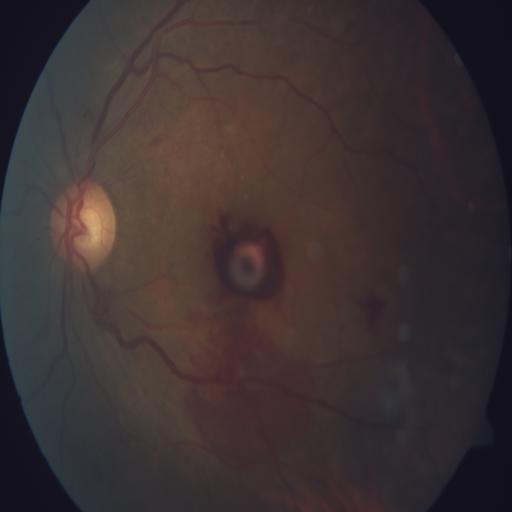 Findings:
- preretinal hemorrhage (PRH)
- hemorrhagic retinopathy (HR)